FOV: 45 degrees · retinal fundus photograph
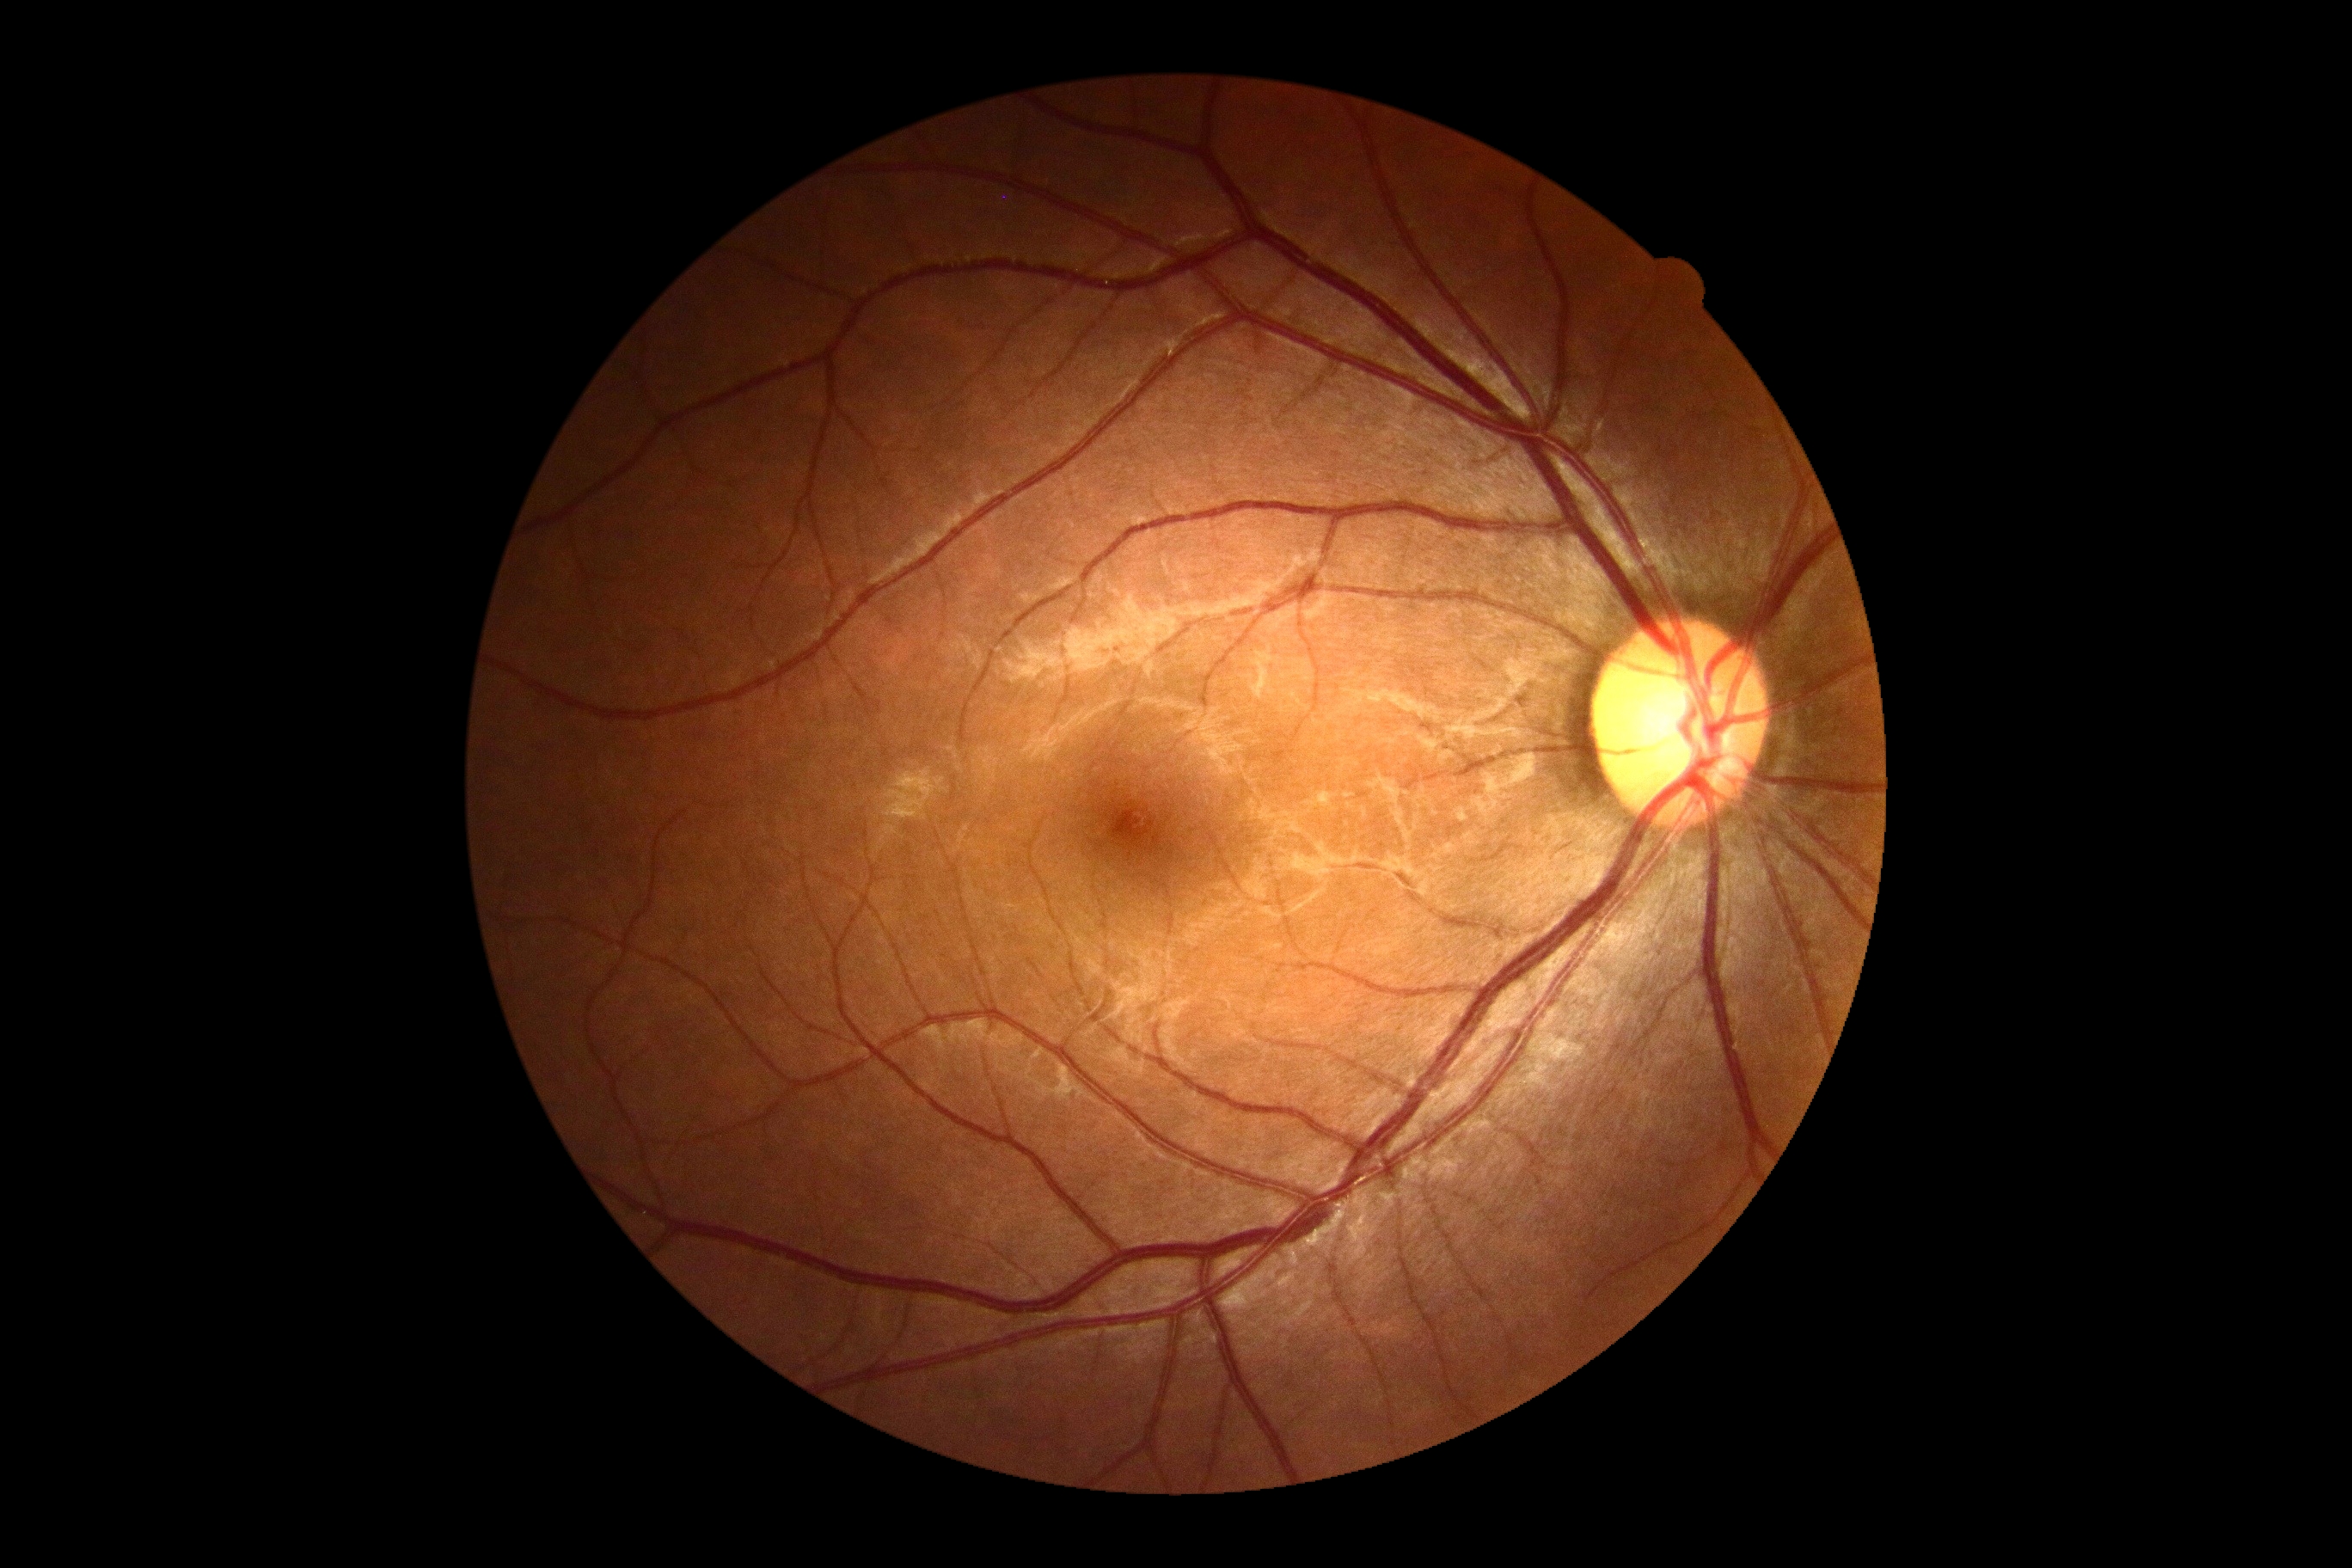 {
  "dr_grade": "grade 0",
  "dr_impression": "negative for DR"
}